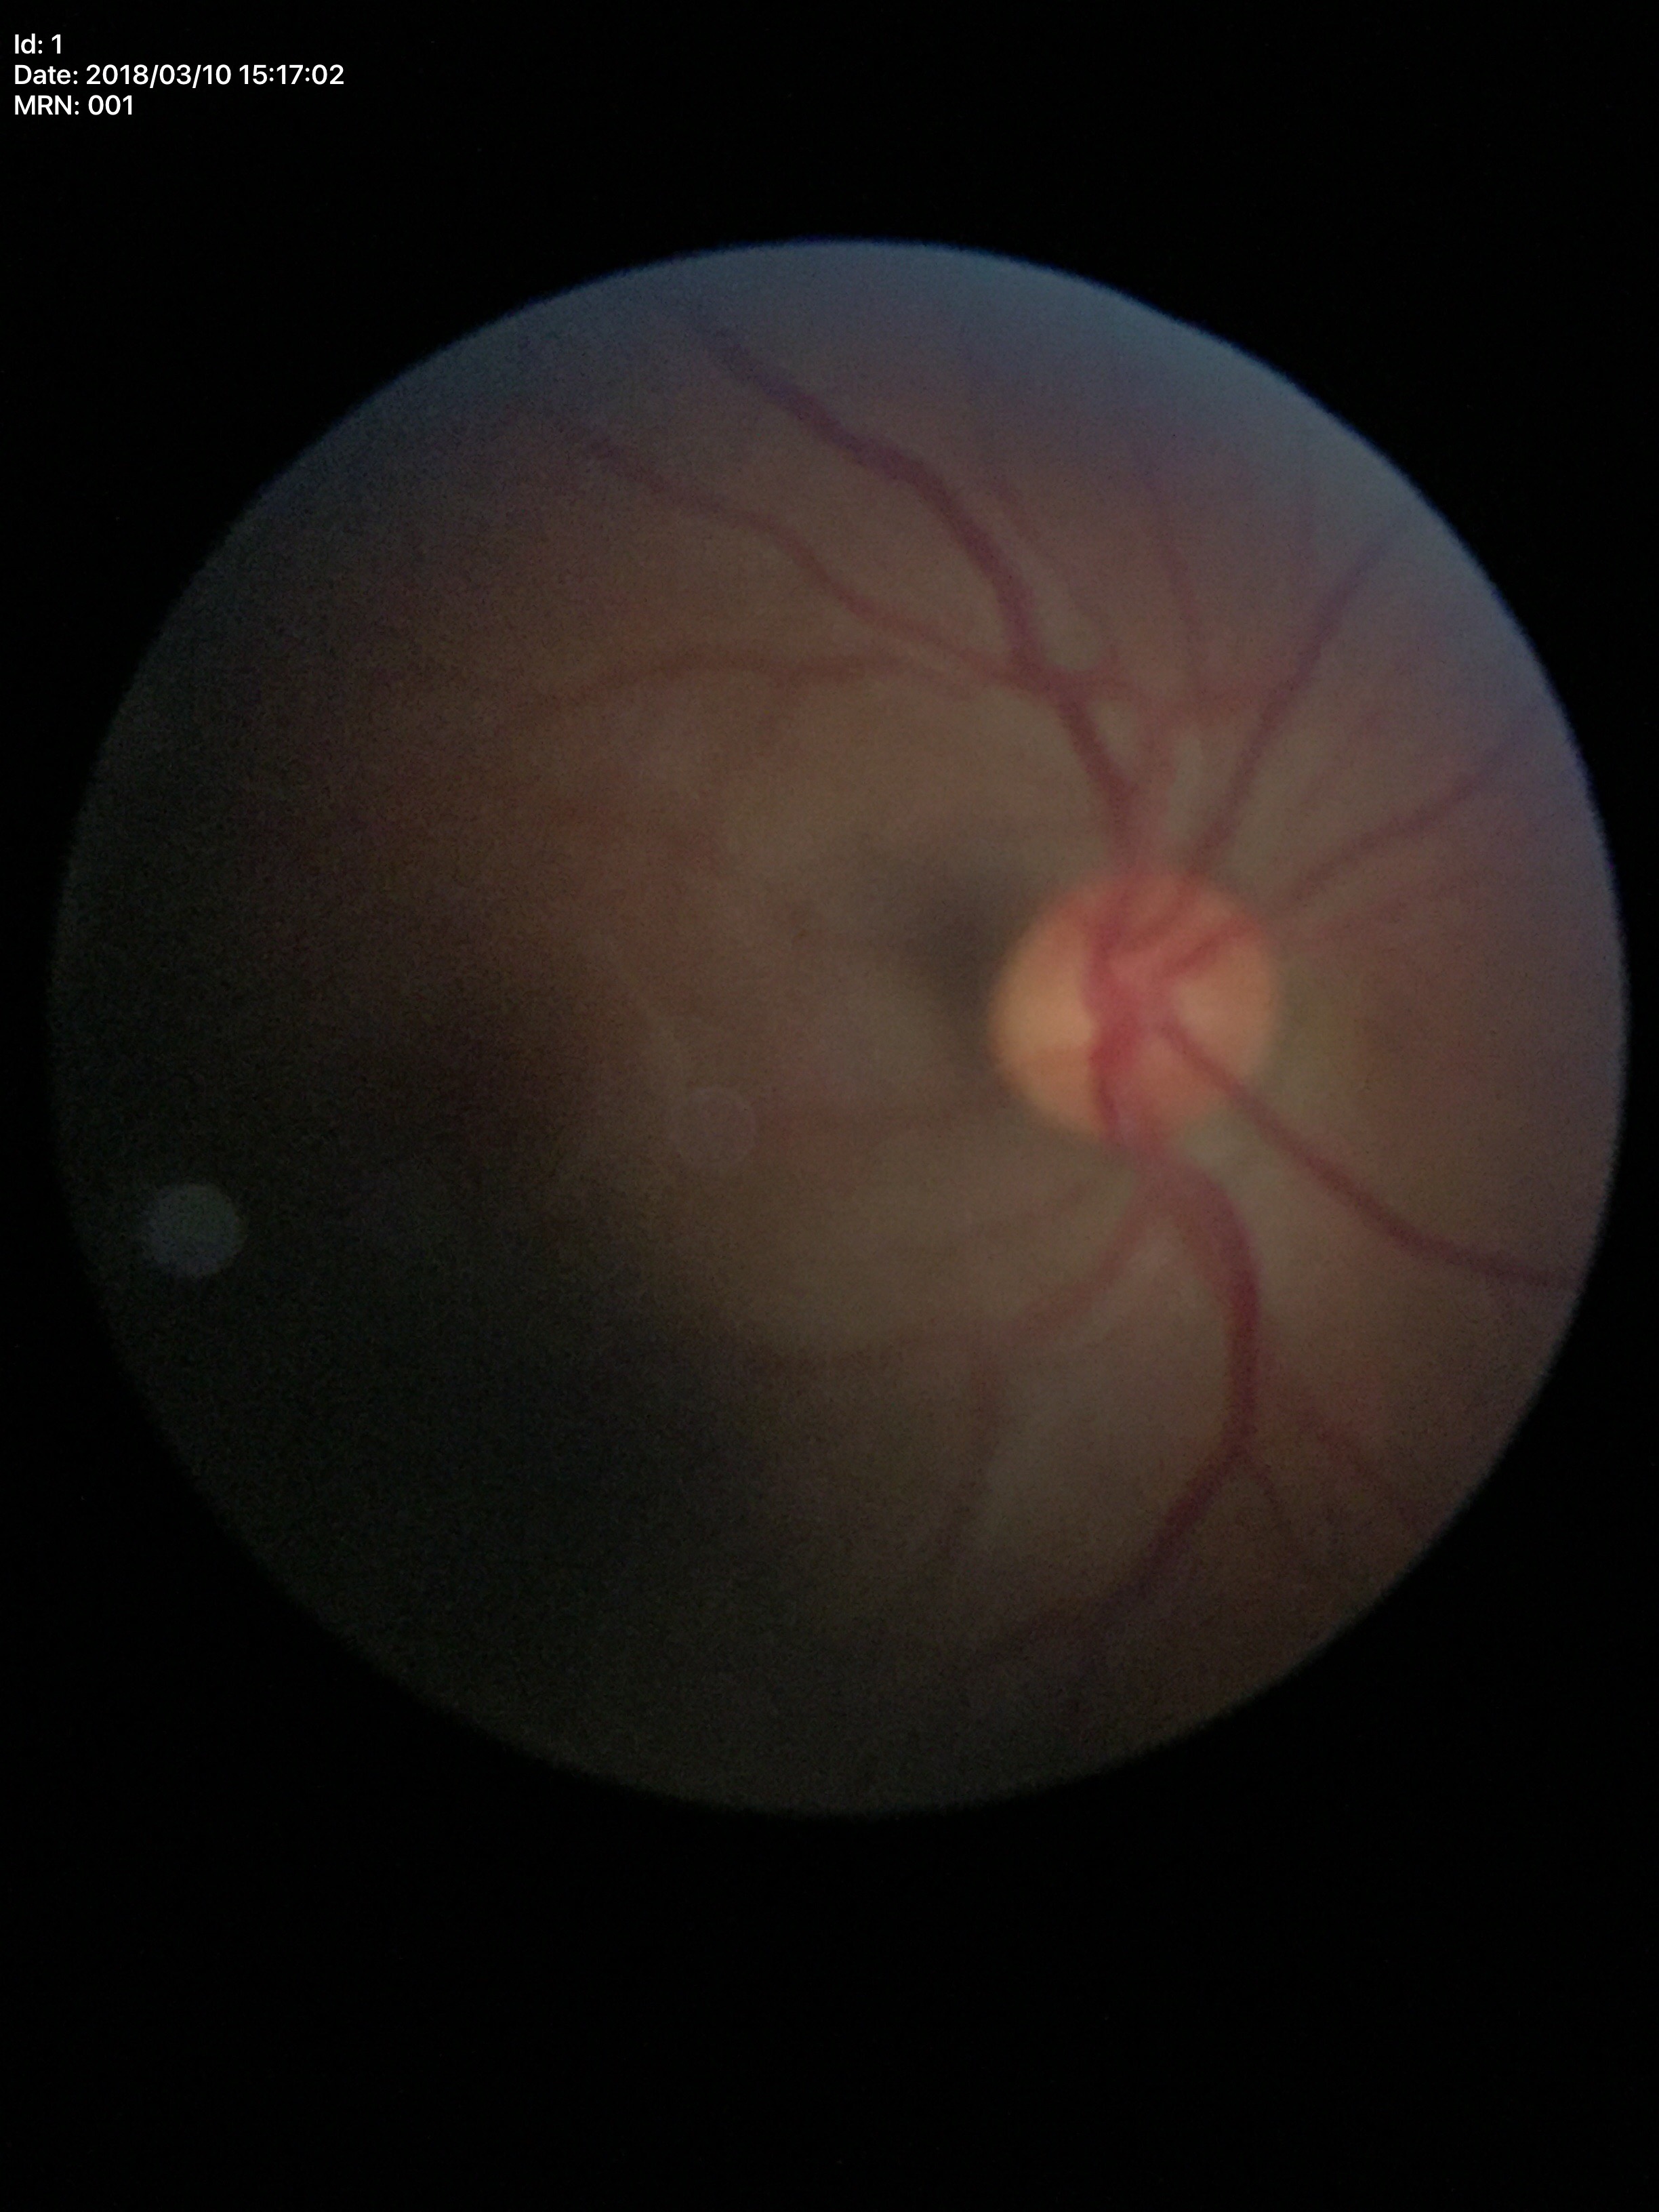 No glaucomatous findings.
Horizontal CDR: 0.51.
Vertical C/D ratio of 0.50.